45-degree field of view. 2212x1659 — 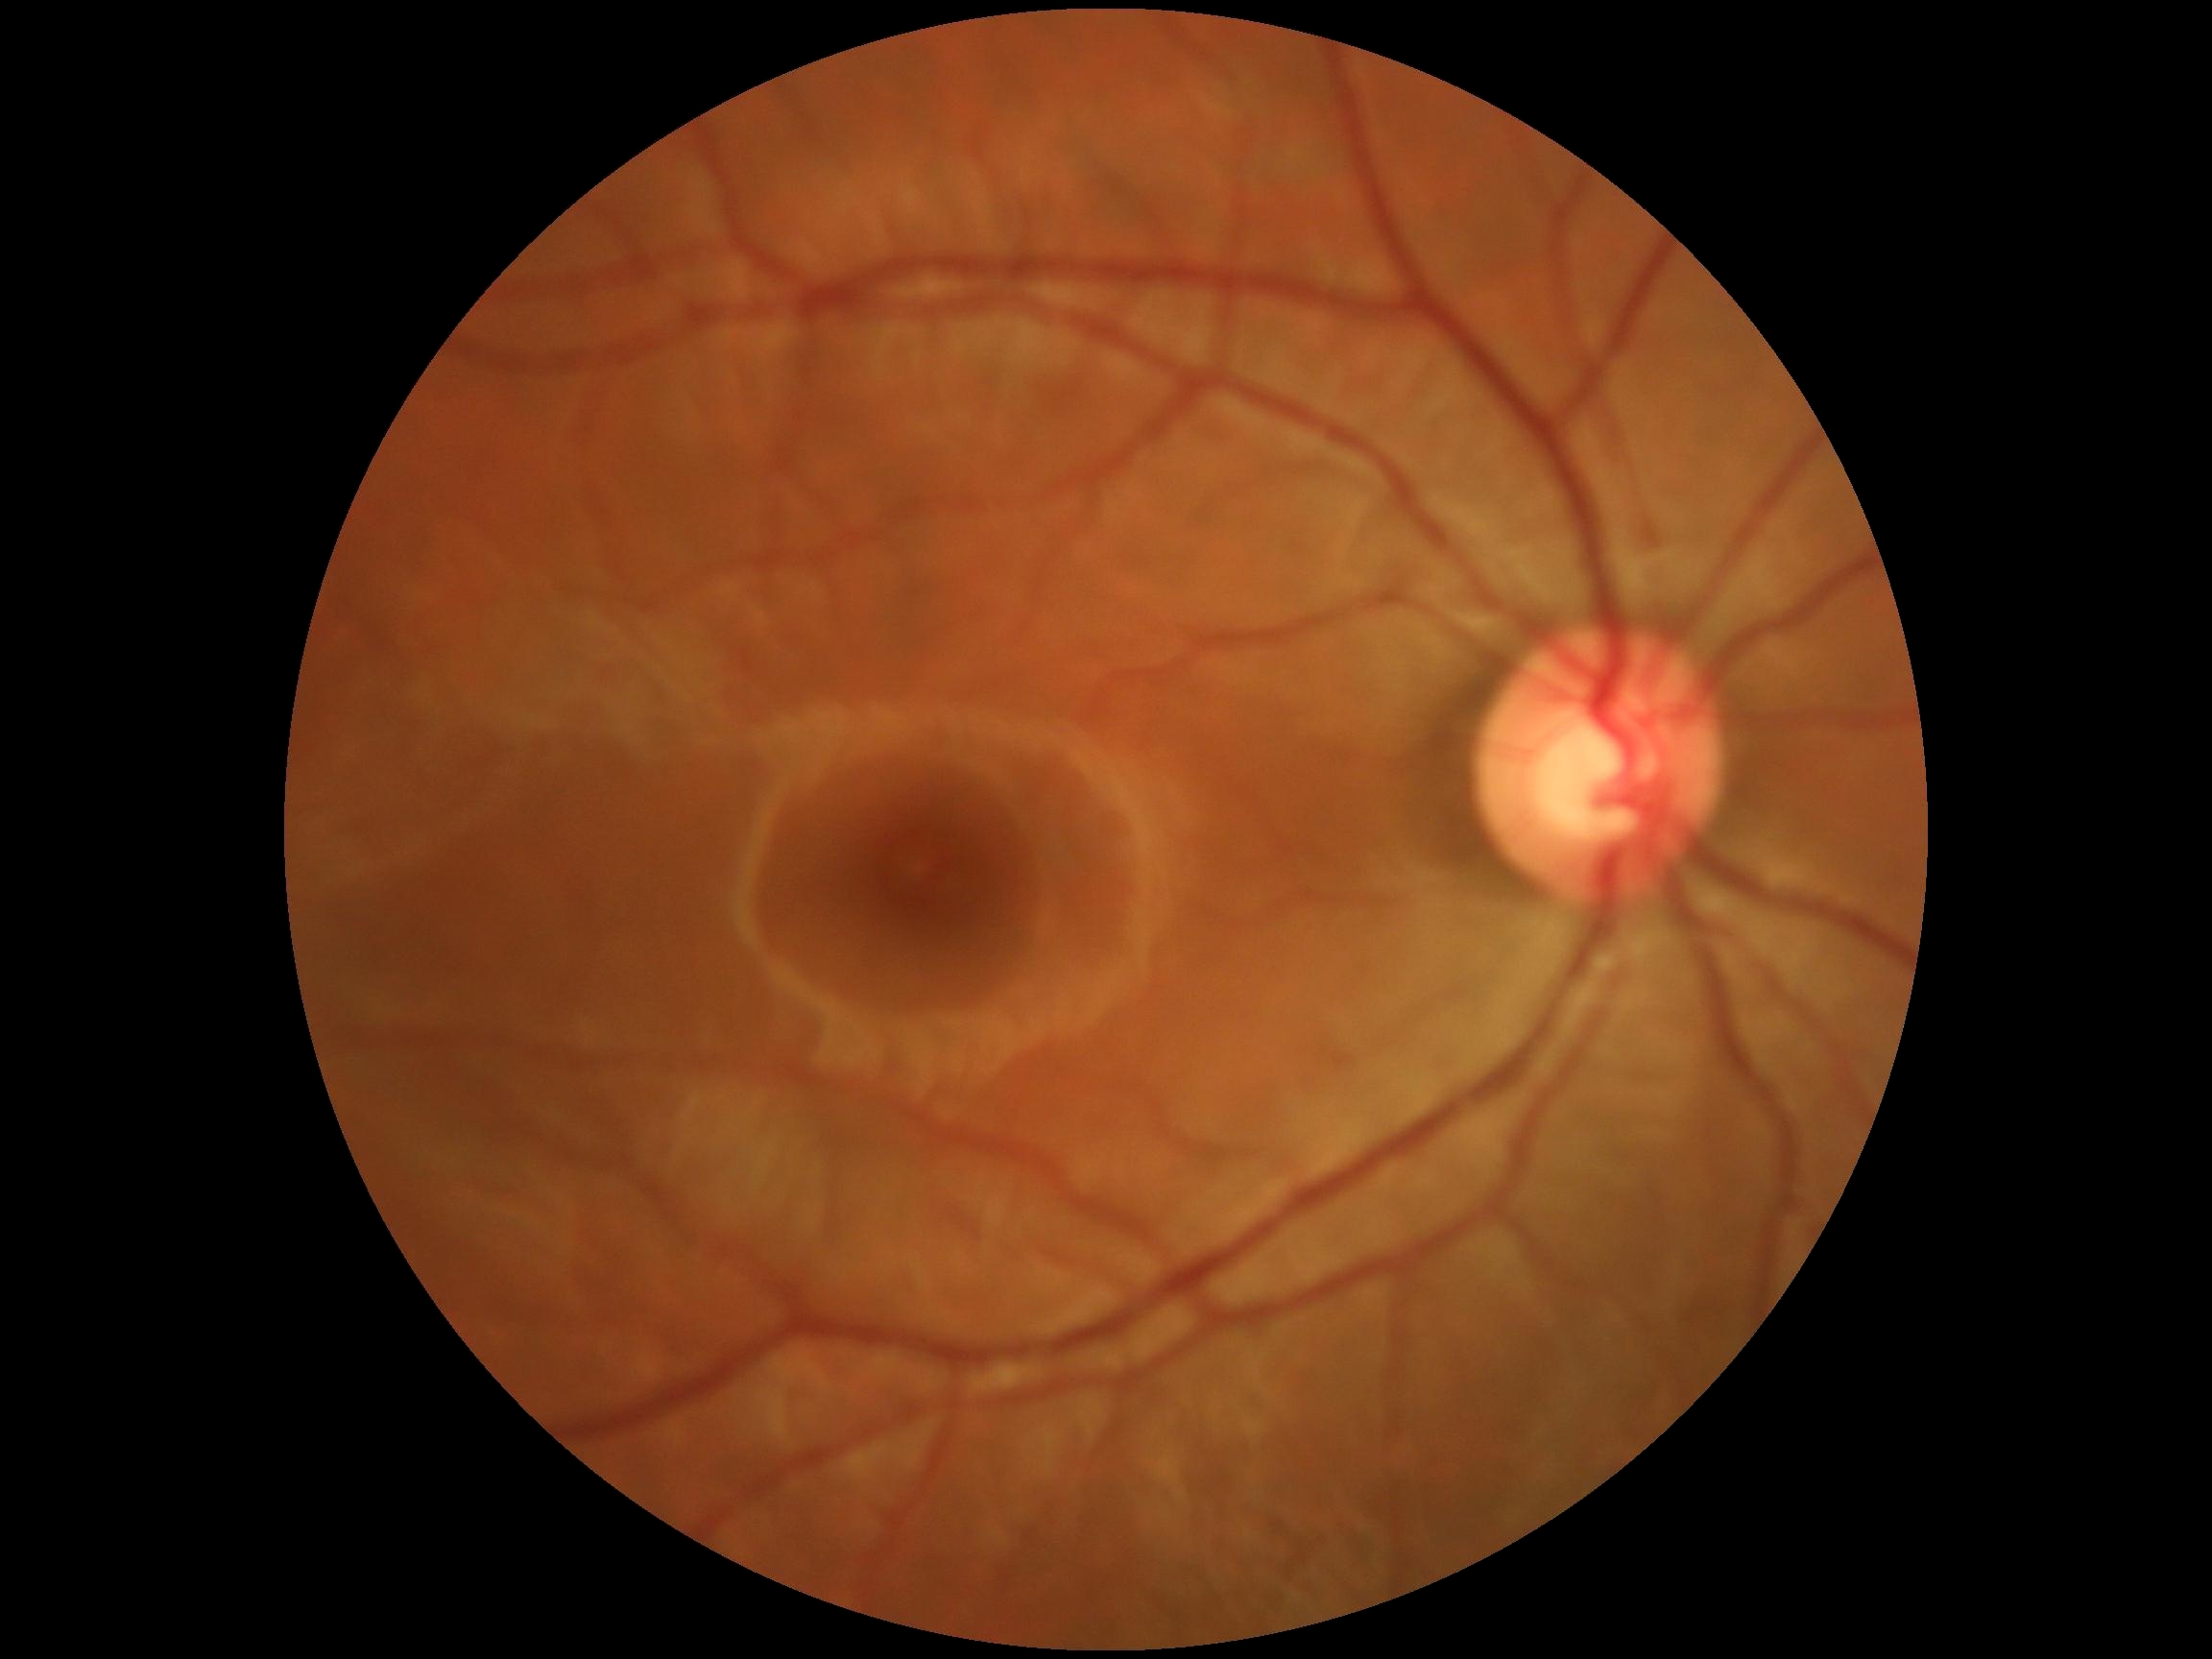

DR severity: no apparent retinopathy (grade 0).